Pediatric retinal photograph (wide-field).
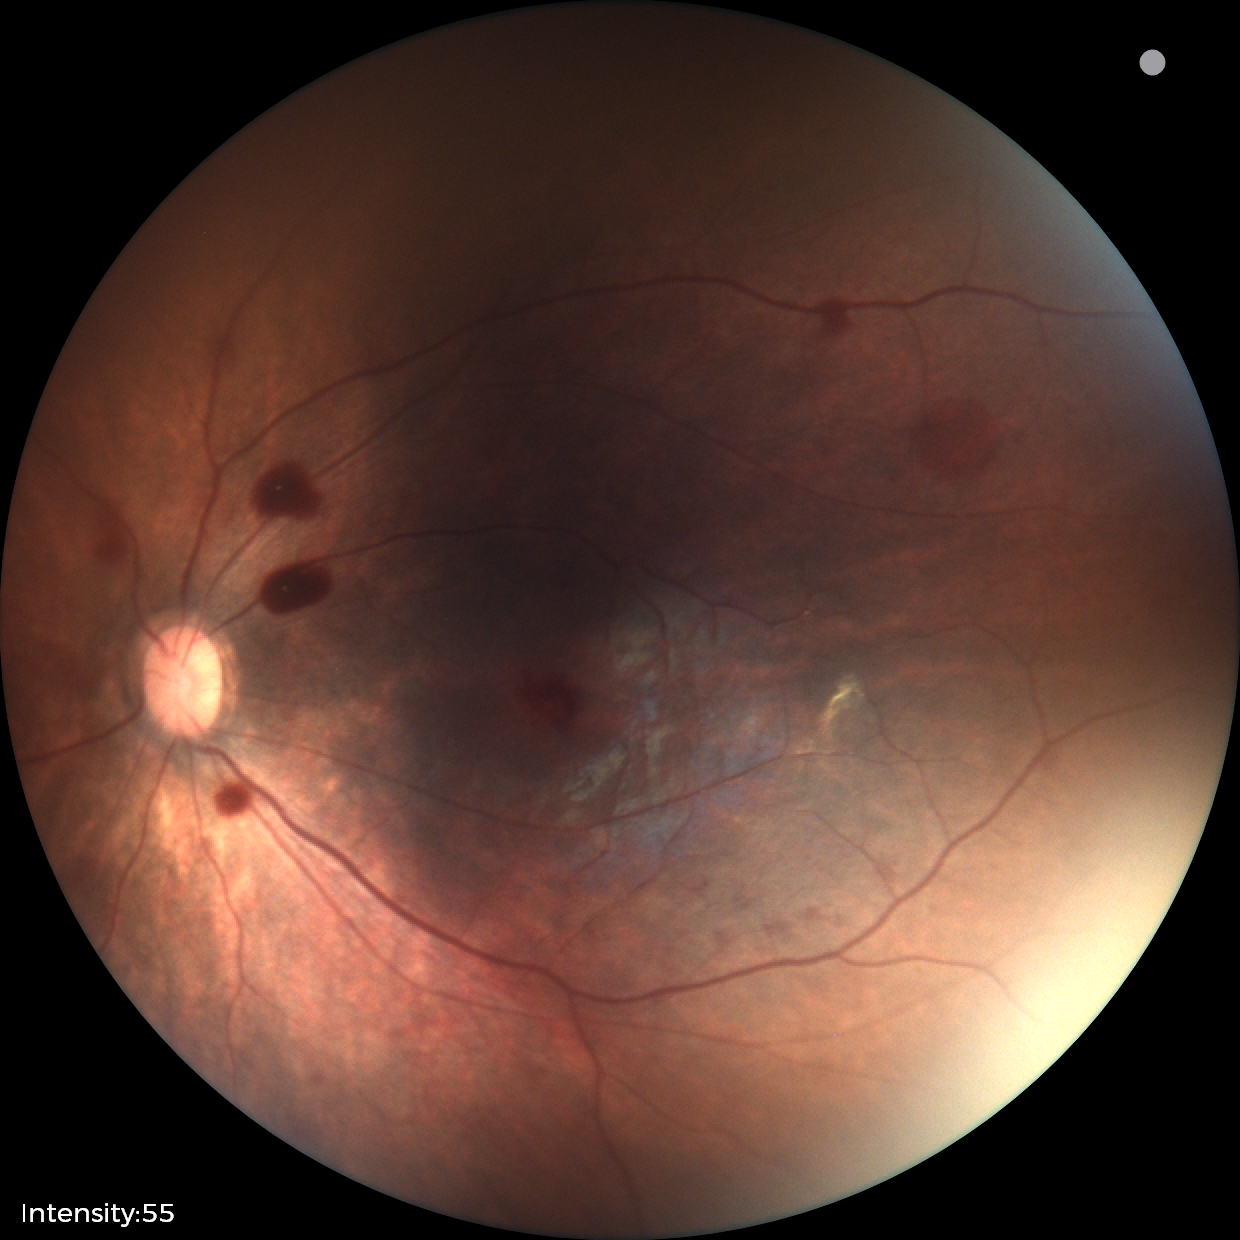

From an examination with diagnosis of retinal hemorrhages.